CFP:
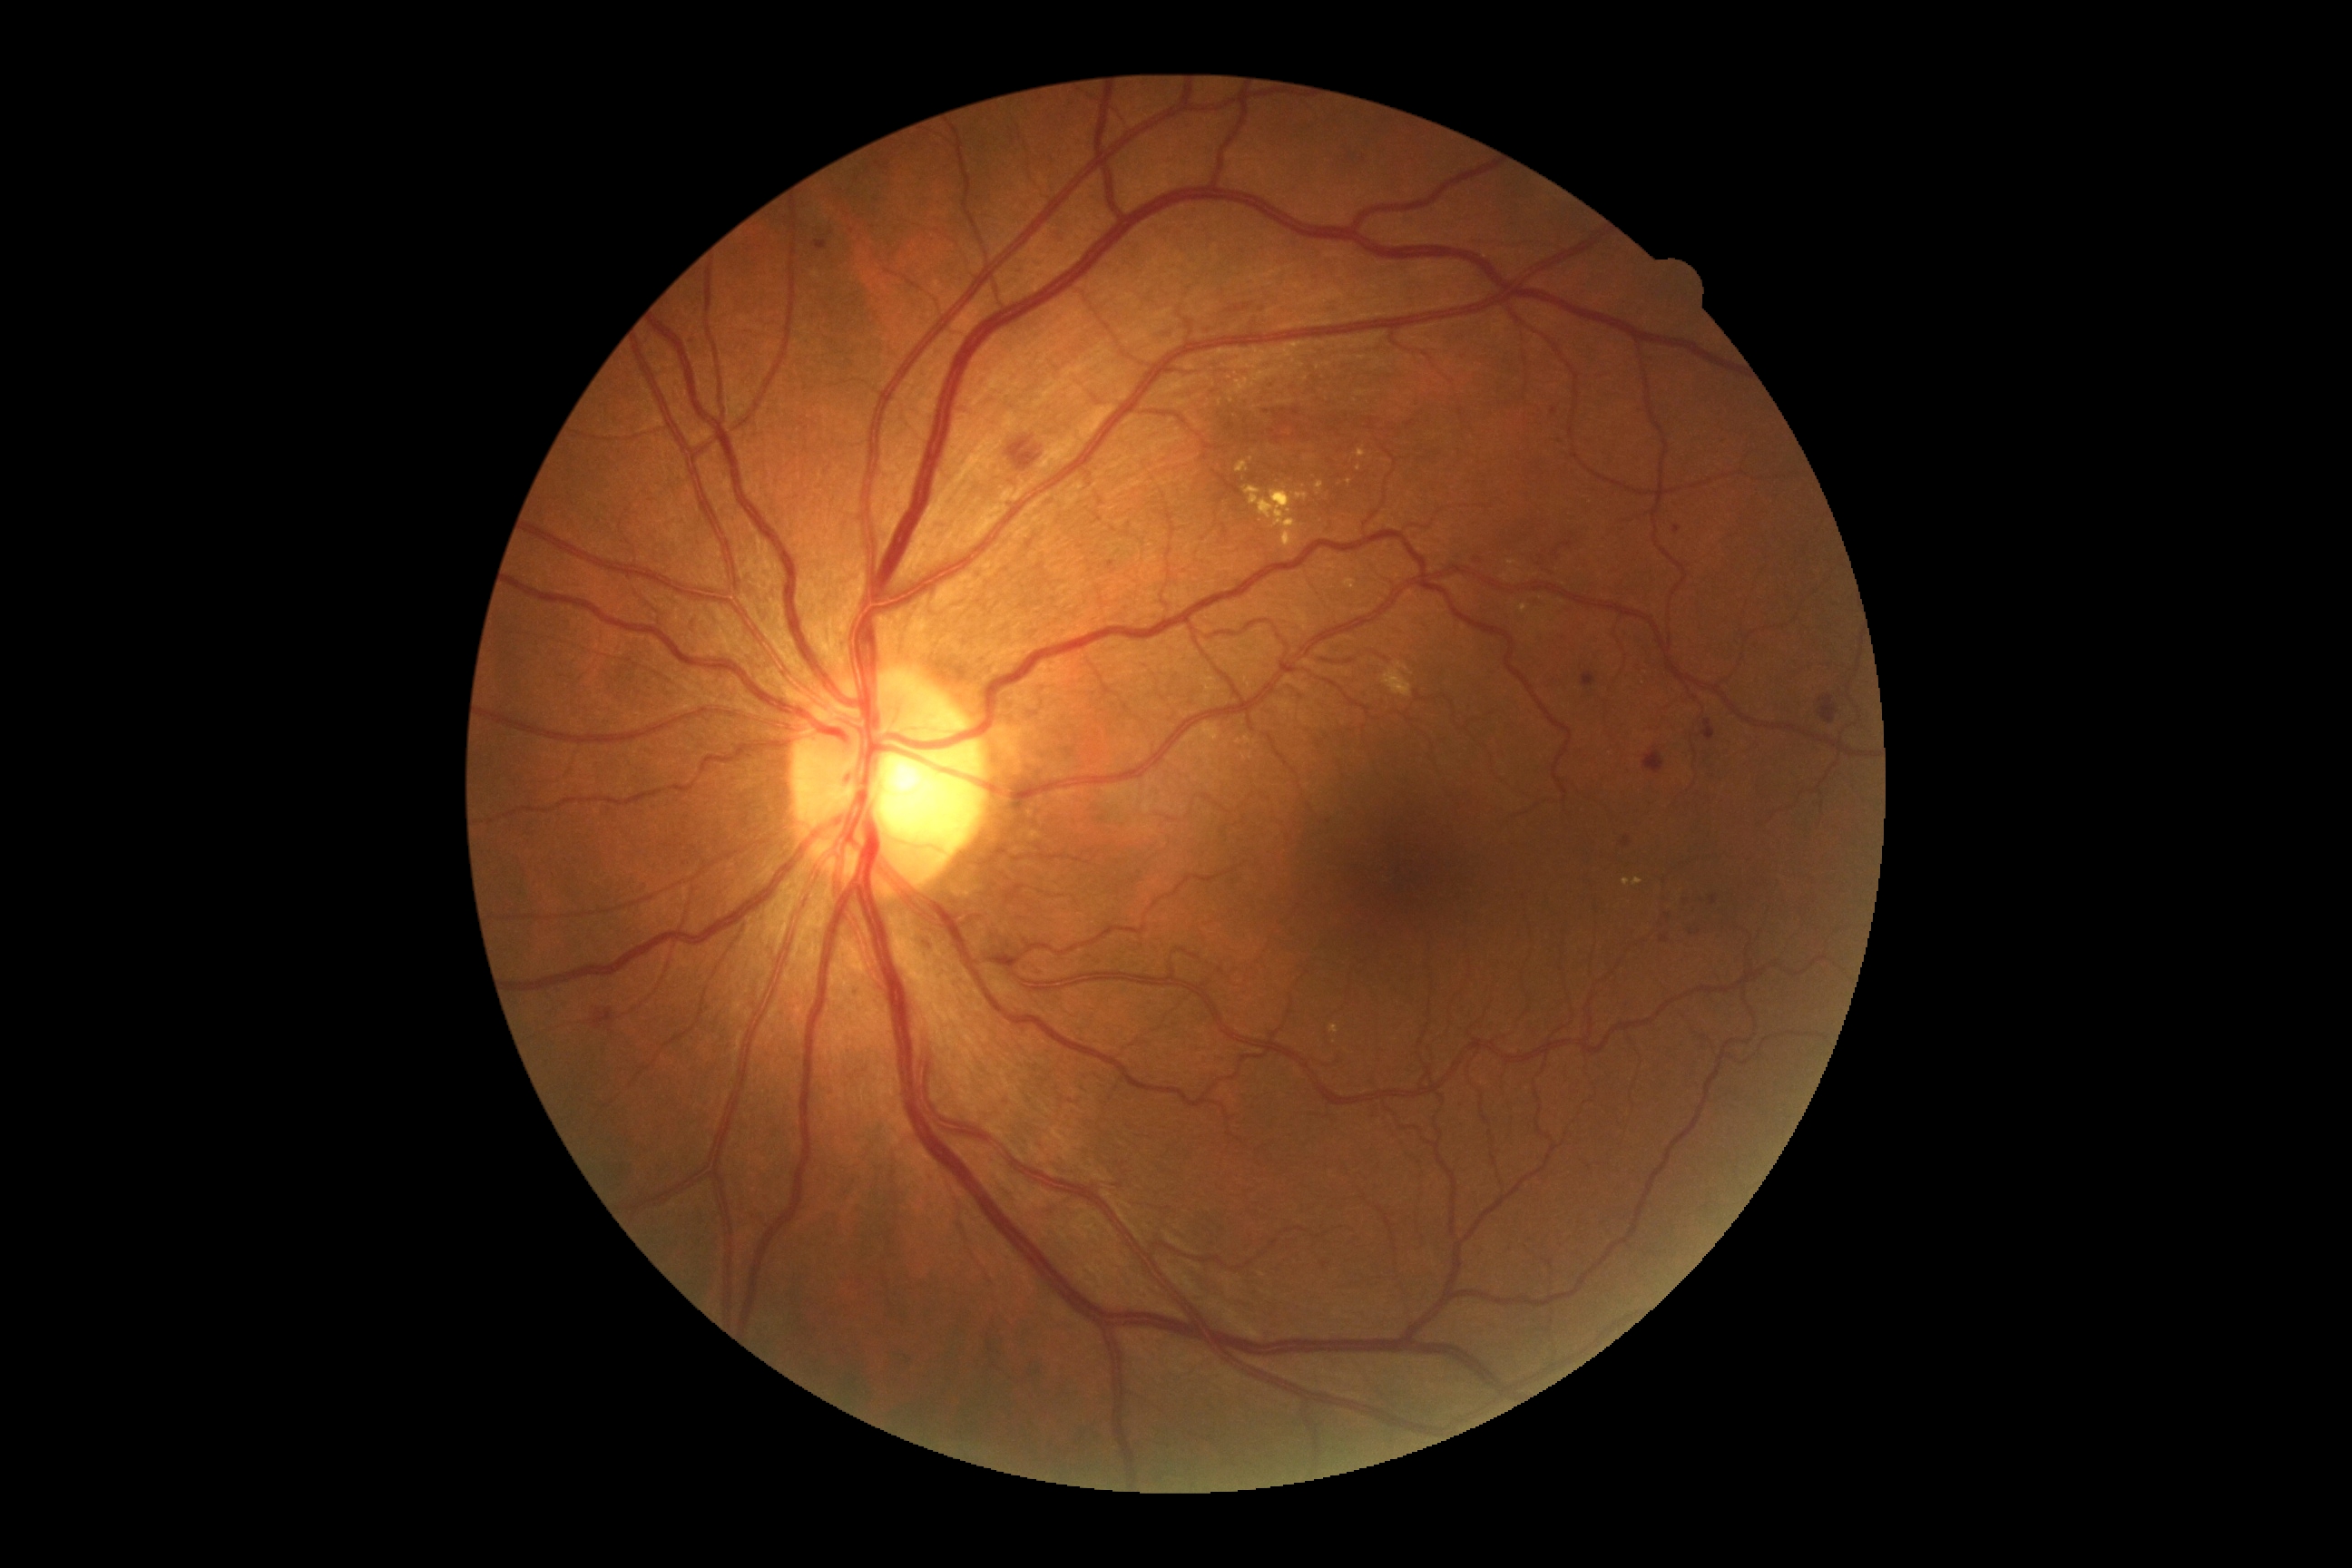 {"partial": true, "dr_grade": 2, "lesions": {"ma": [[1583, 672, 1596, 687], [1681, 897, 1689, 905], [814, 240, 828, 251], [1553, 407, 1558, 415], [1672, 527, 1681, 534], [1556, 438, 1567, 446], [1710, 896, 1718, 905], [874, 161, 883, 168], [1660, 937, 1671, 943], [1108, 562, 1115, 573], [1622, 836, 1631, 848]], "ma_small_approx": [[1205, 457], [1692, 933], [1478, 561], [1668, 916], [888, 167], [1703, 900]], "he": [[1273, 411, 1289, 427], [1701, 720, 1716, 741], [593, 1008, 616, 1032], [1643, 749, 1665, 774], [1819, 696, 1838, 723], [1291, 409, 1300, 416], [1269, 429, 1282, 444], [1008, 436, 1043, 473]], "he_small_approx": [[1283, 412], [1266, 412]], "ex": [[1520, 605, 1529, 614], [1632, 877, 1643, 887], [1382, 662, 1413, 698], [1623, 879, 1631, 887], [1317, 480, 1324, 496], [1507, 560, 1518, 565], [1357, 447, 1367, 458], [1244, 485, 1309, 547], [1329, 1026, 1340, 1034], [1237, 456, 1253, 473], [1304, 456, 1317, 462]], "ex_small_approx": [[1359, 469], [1504, 579], [1348, 482], [1512, 571], [1256, 453]], "se": null}}